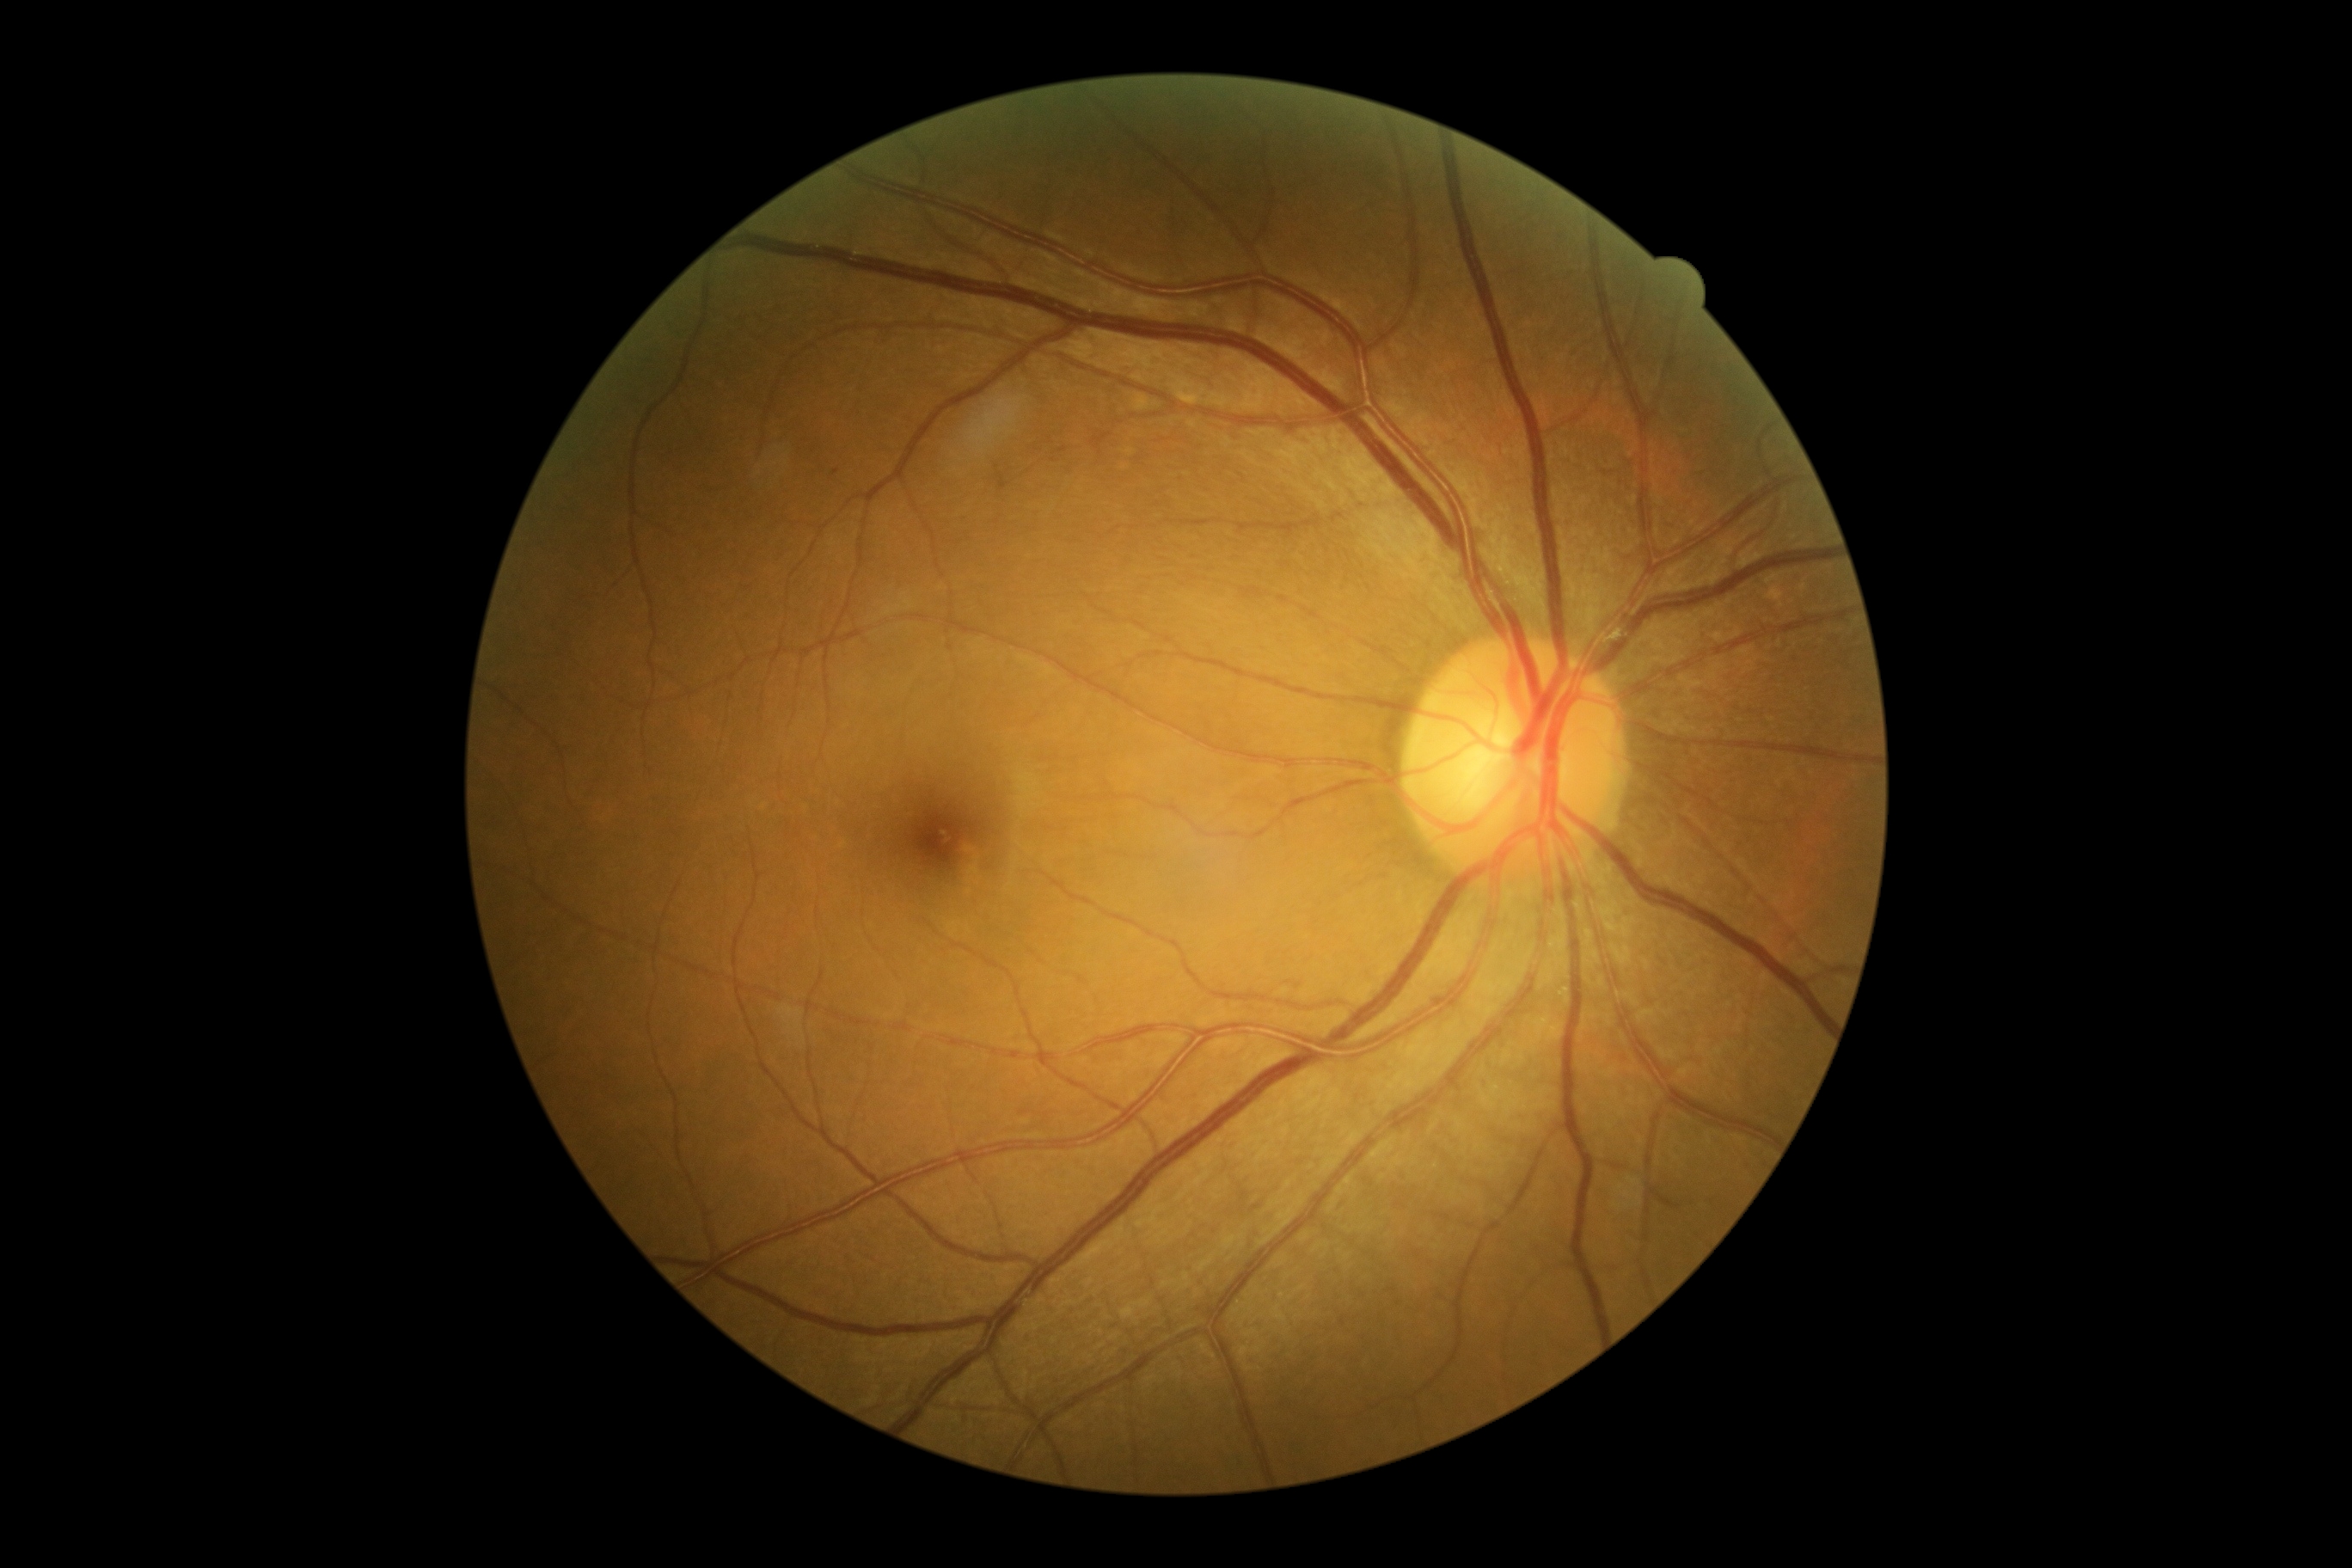 DR severity is no apparent retinopathy (grade 0).